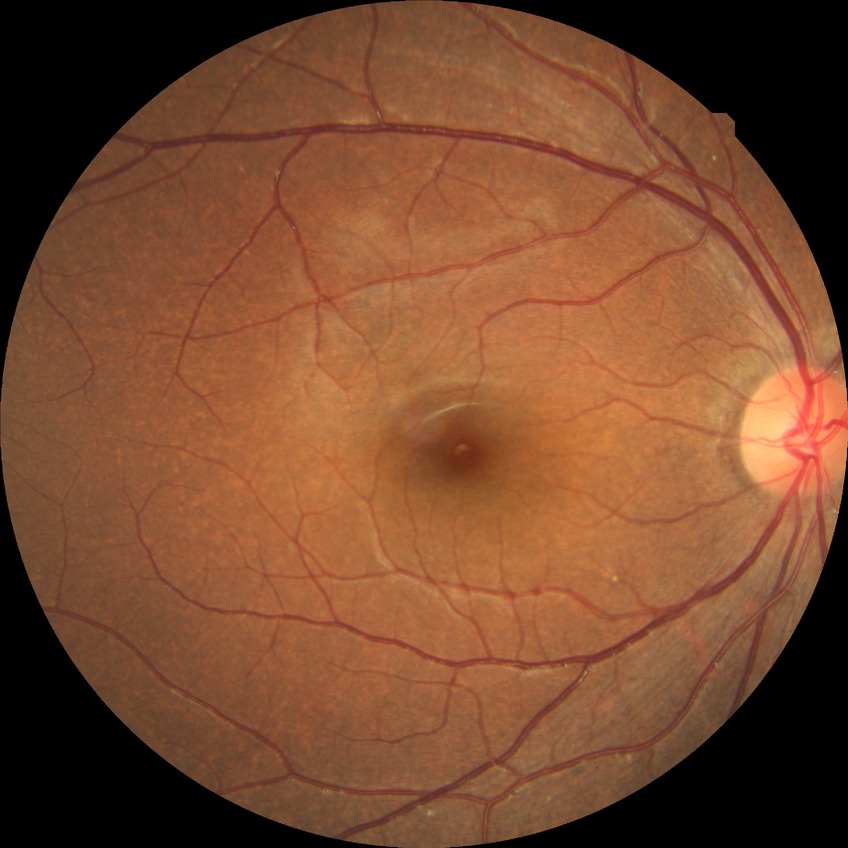 Assessment:
- Davis stage — NDR